45-degree field of view. Camera: NIDEK AFC-230. Nonmydriatic fundus photograph. 848x848. Retinal fundus photograph:
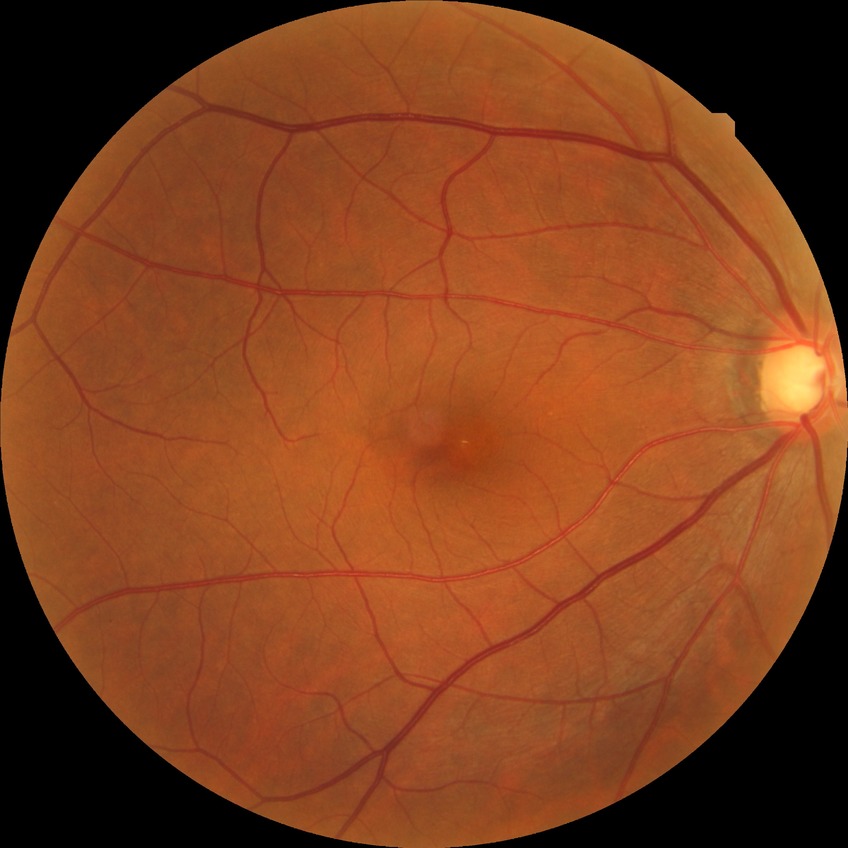
Modified Davis classification is no diabetic retinopathy.